Non-mydriatic acquisition:
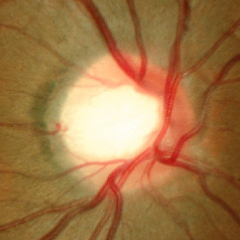

Diagnosis: no signs of glaucoma.